Image size 2048x1536.
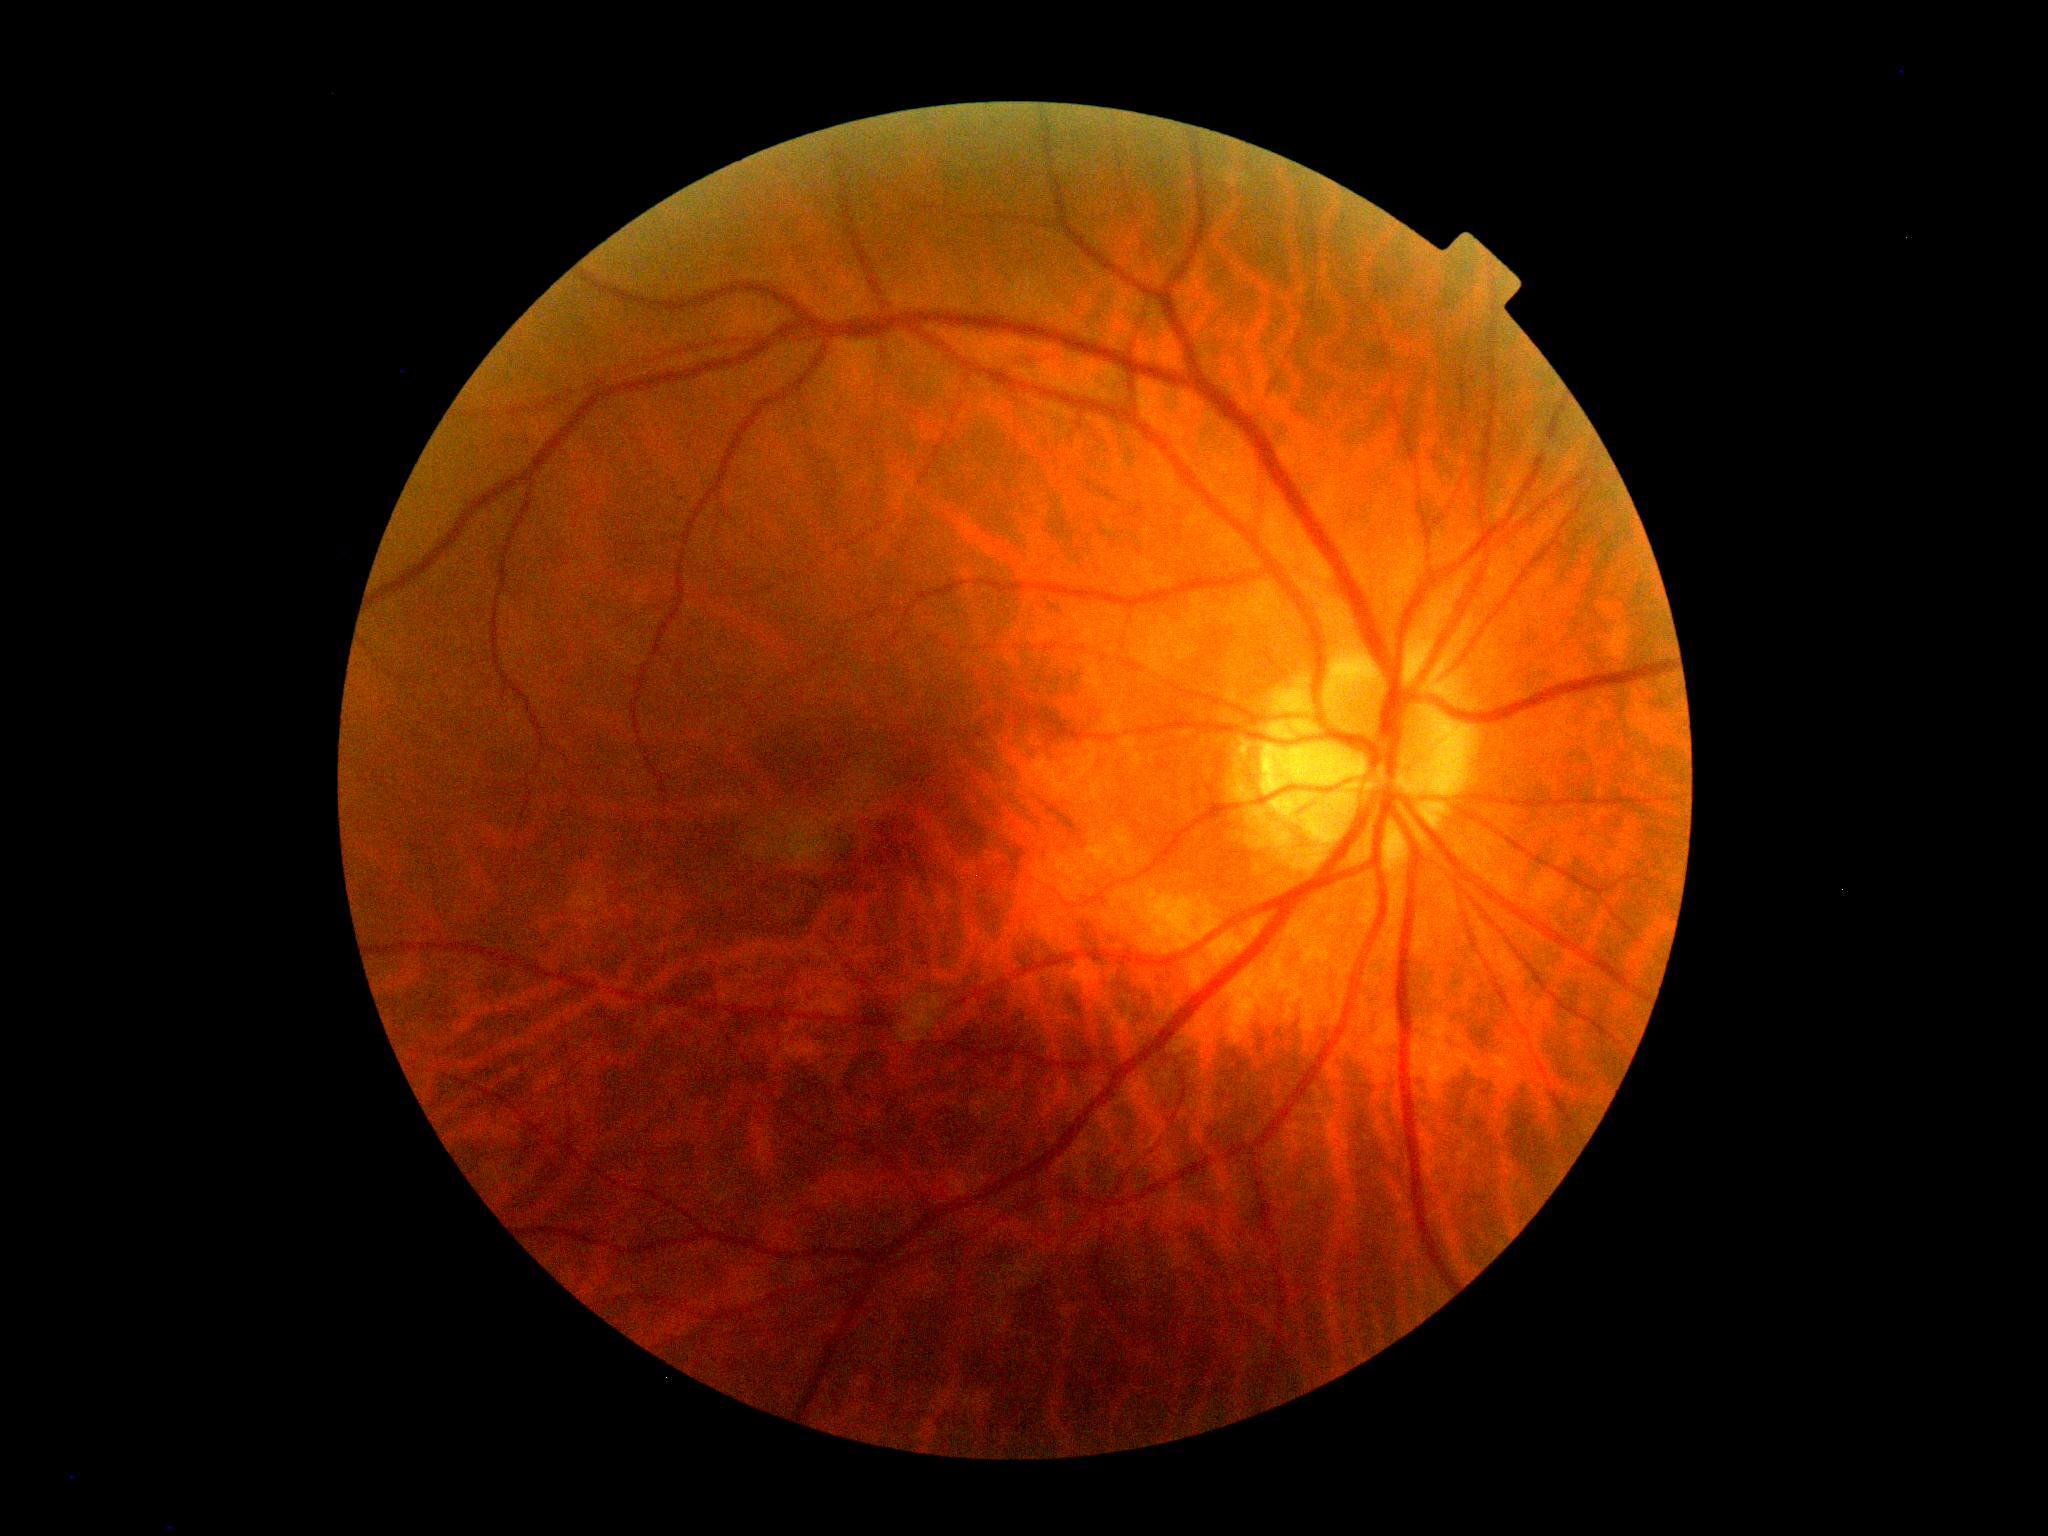 {
  "dr_grade": "0"
}